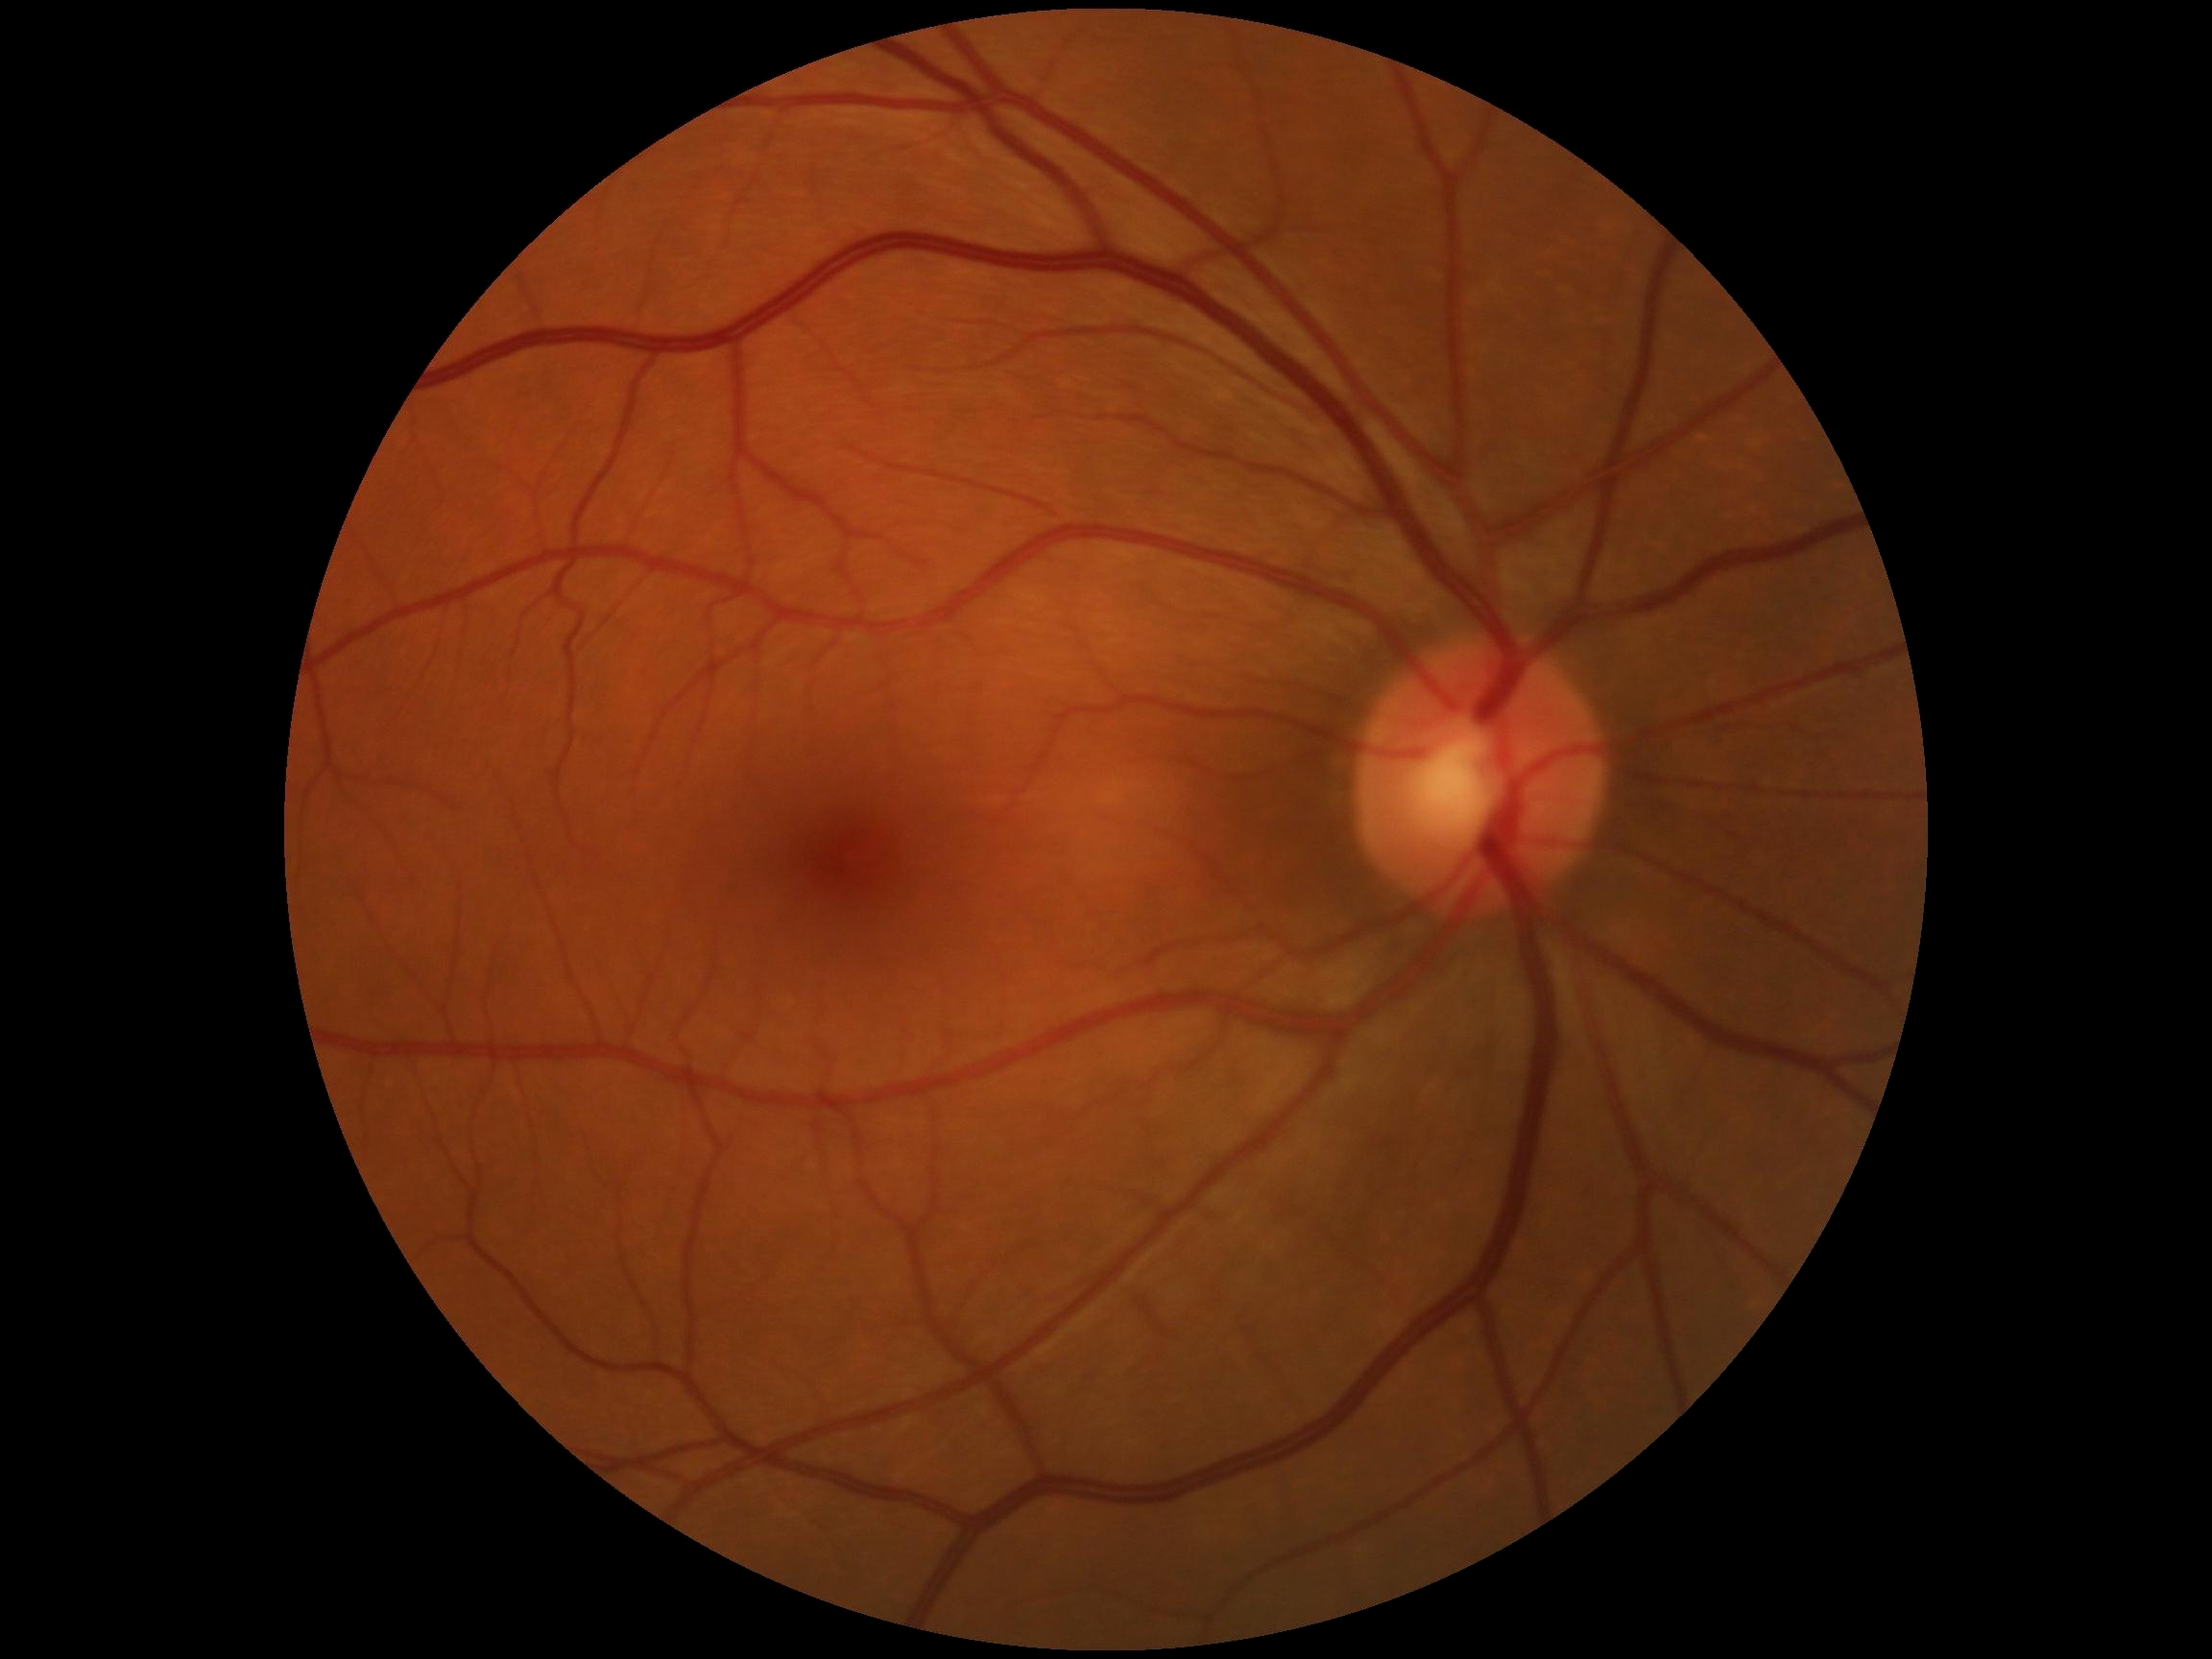 Diabetic retinopathy (DR) is 0/4.